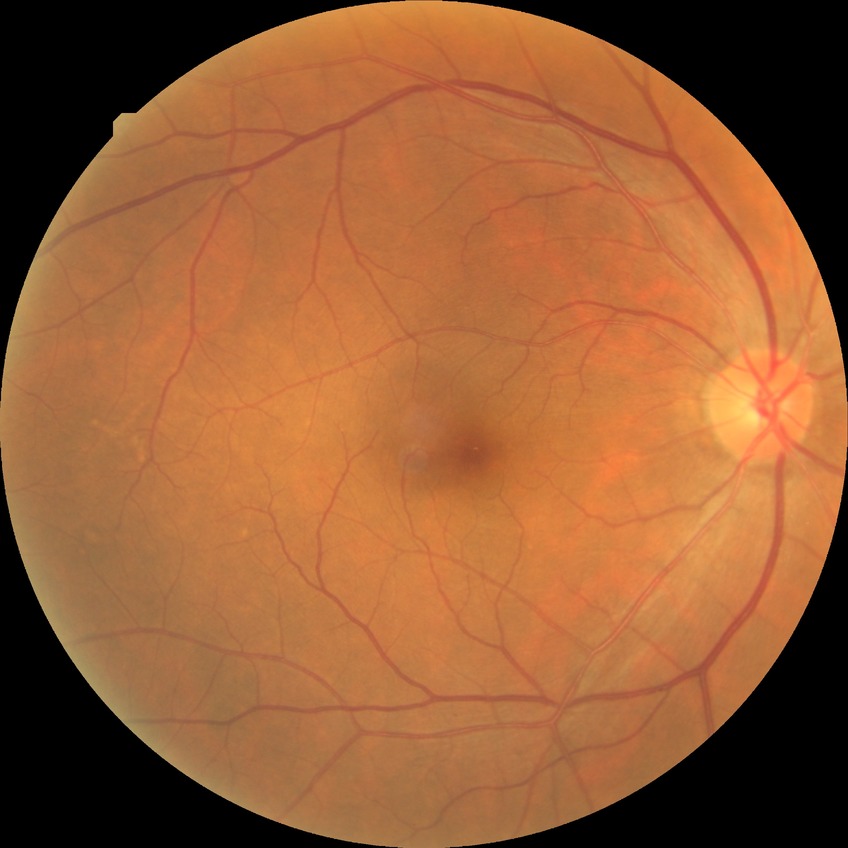 Diabetic retinopathy (DR) is no diabetic retinopathy (NDR).